1932 by 1916 pixels: 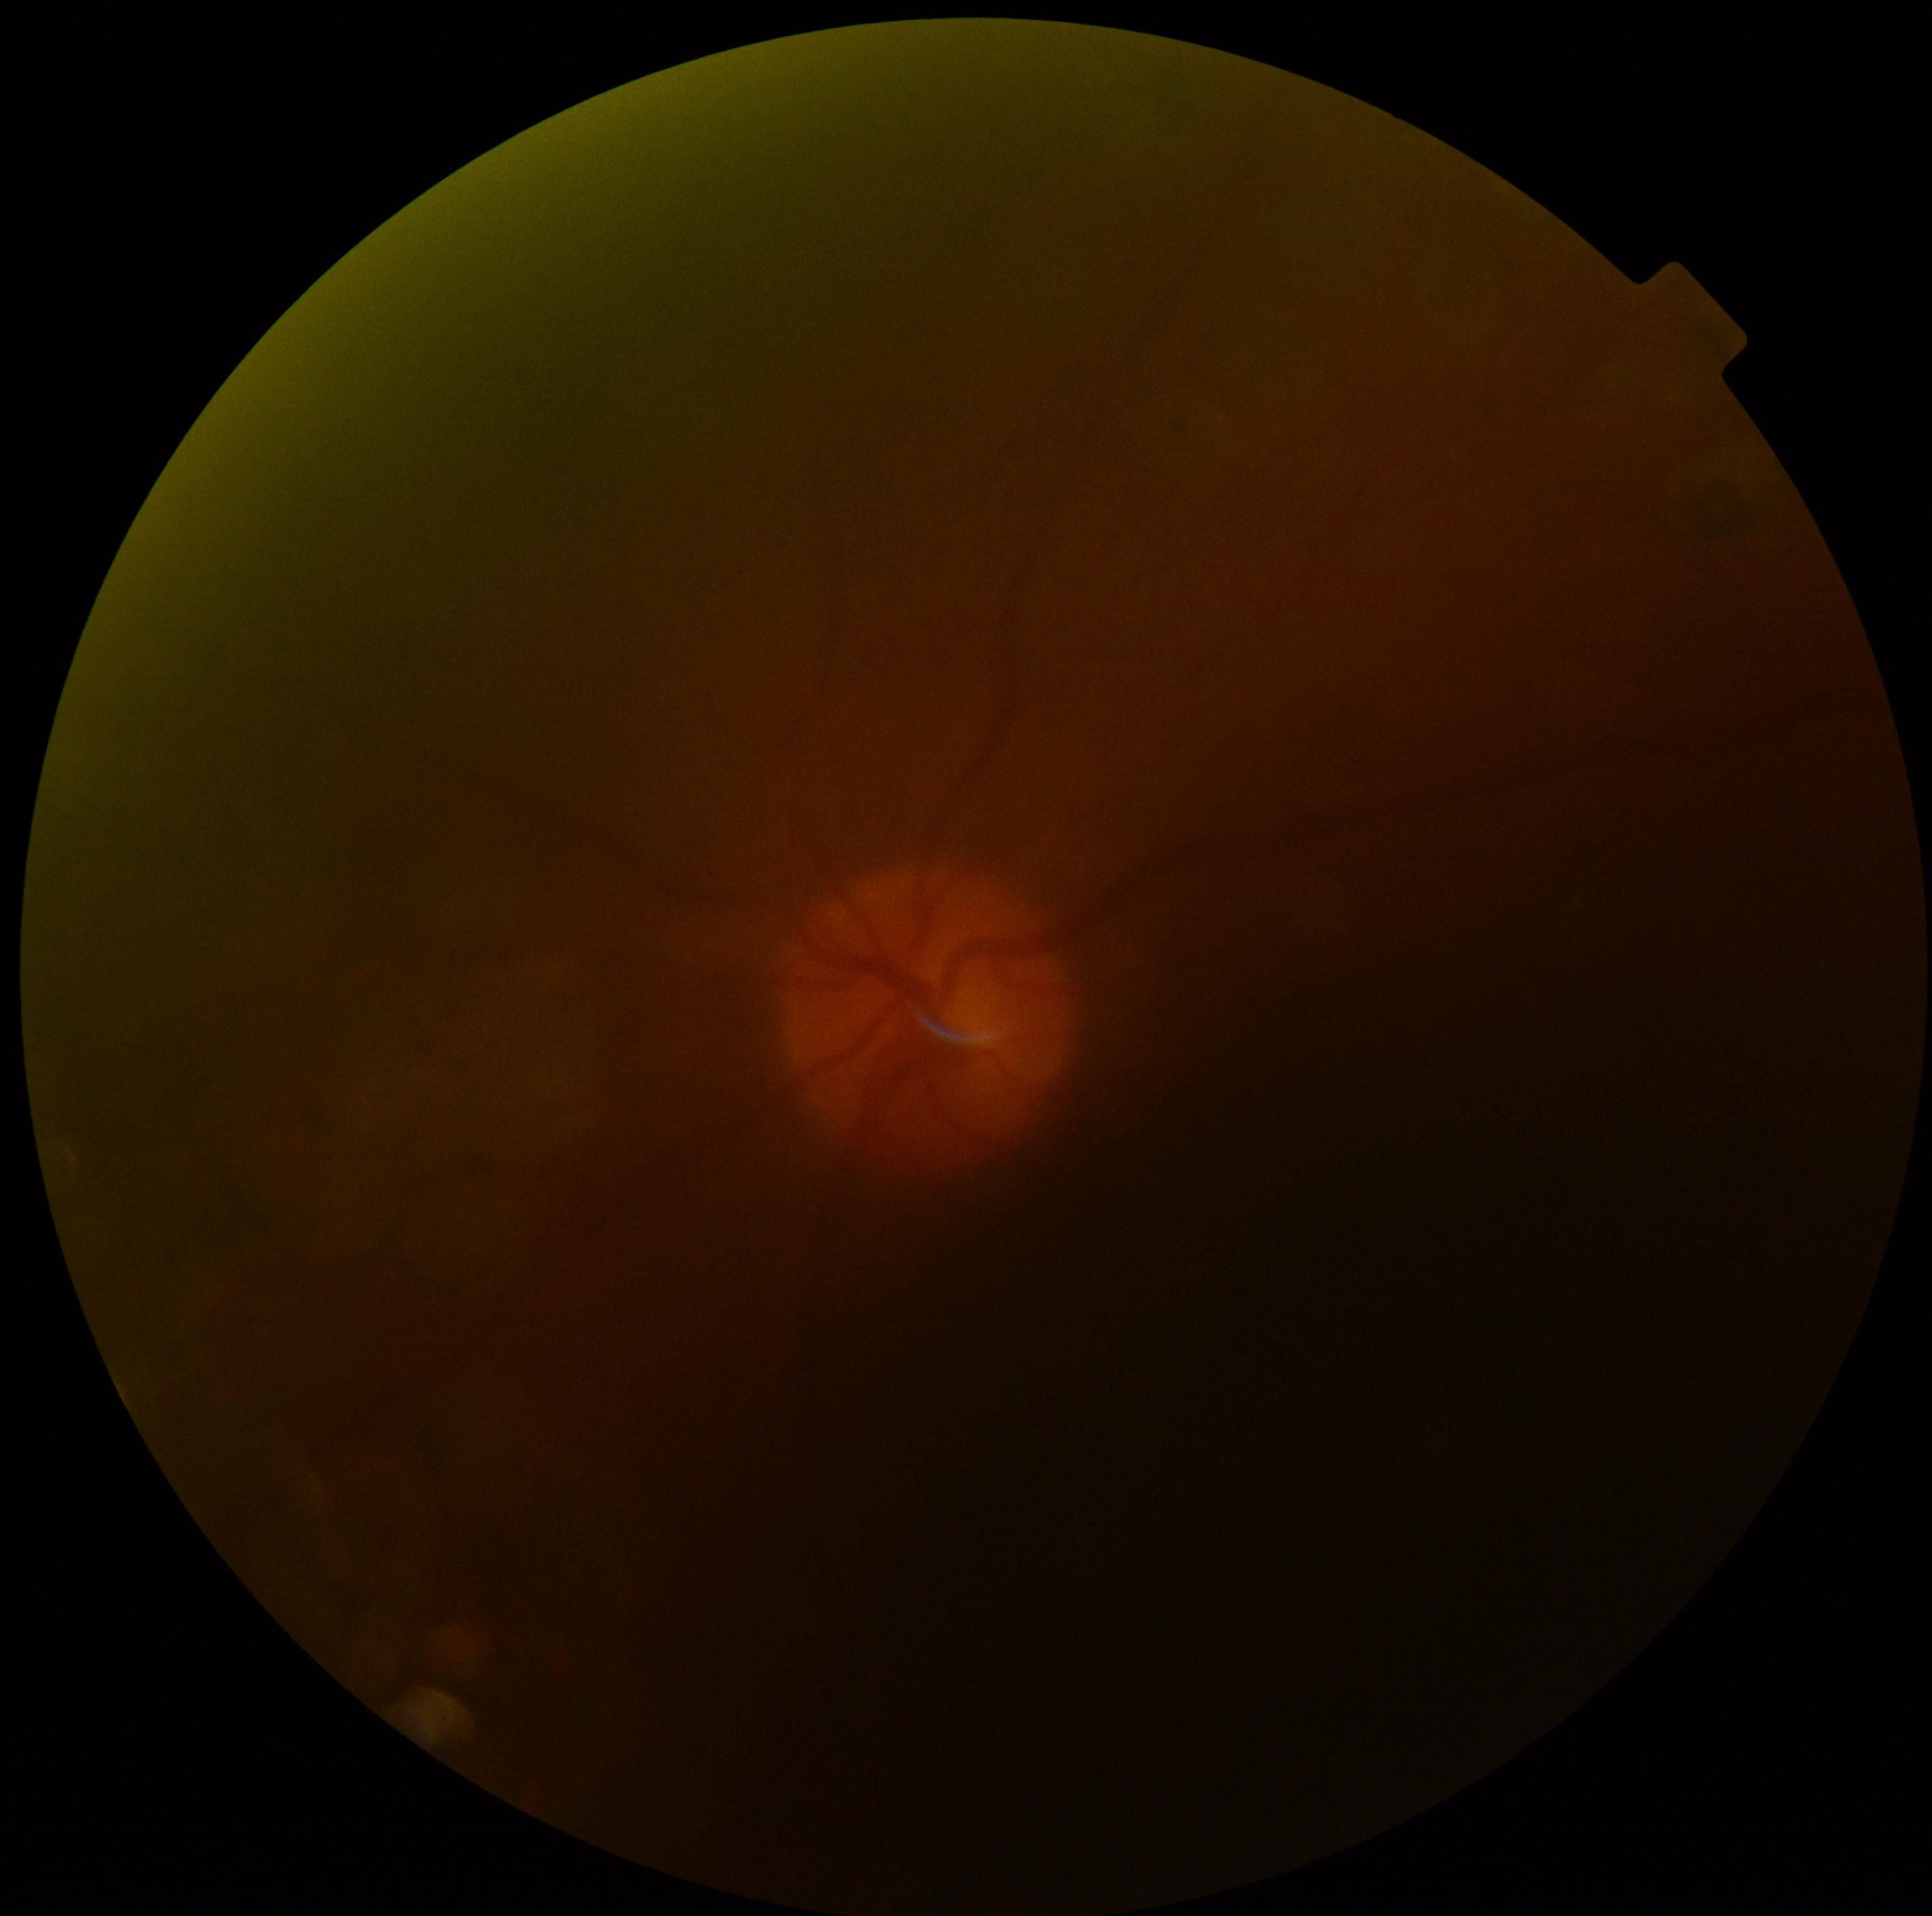 image quality@below grading threshold, retinopathy grade@ungradable due to poor image quality.